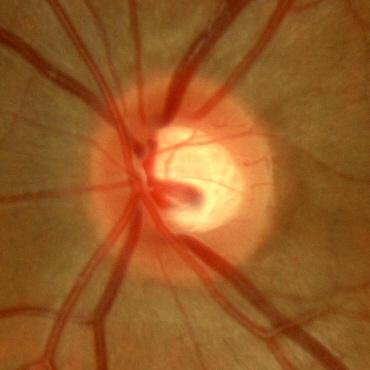 Glaucoma status = no signs of glaucoma.